Diabetic retinopathy graded by the modified Davis classification: 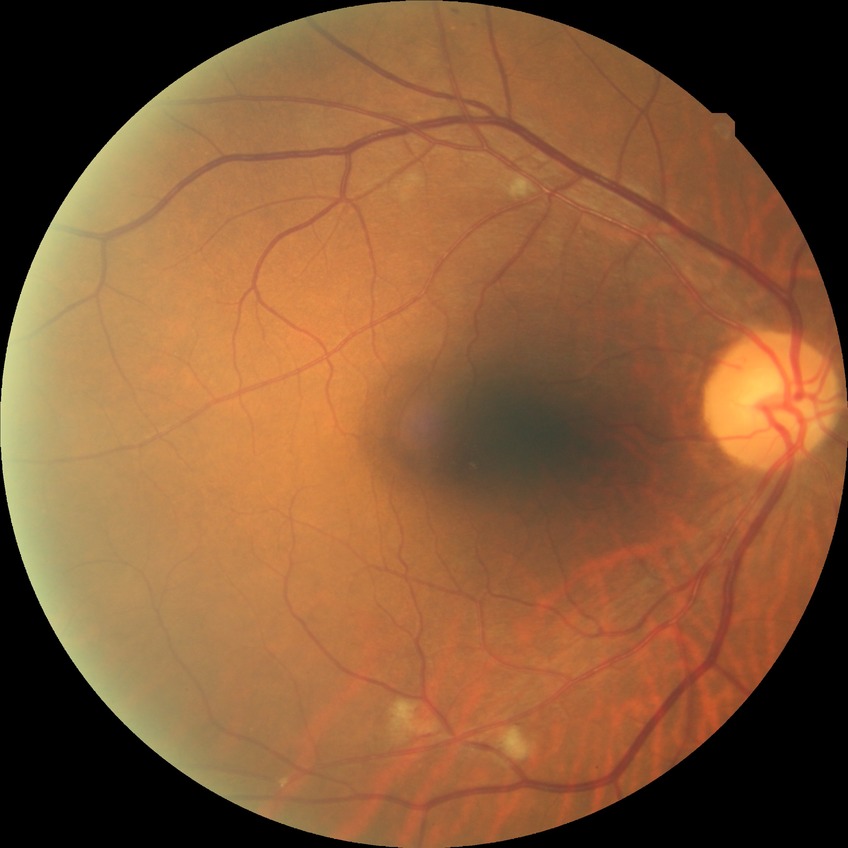

modified Davis classification=pre-proliferative diabetic retinopathy.